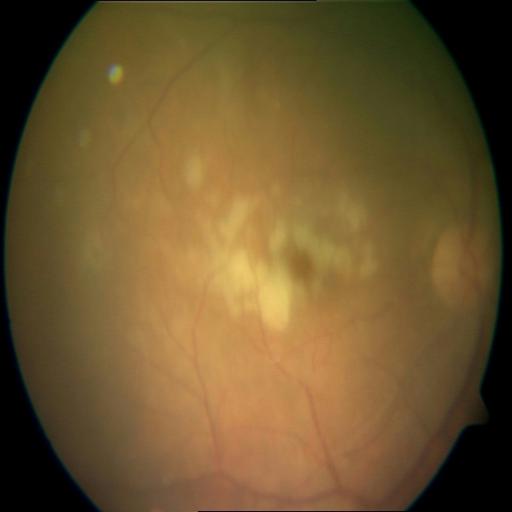
Impression: media haze.